Wide-field contact fundus photograph of an infant; camera: Phoenix ICON (100° FOV): 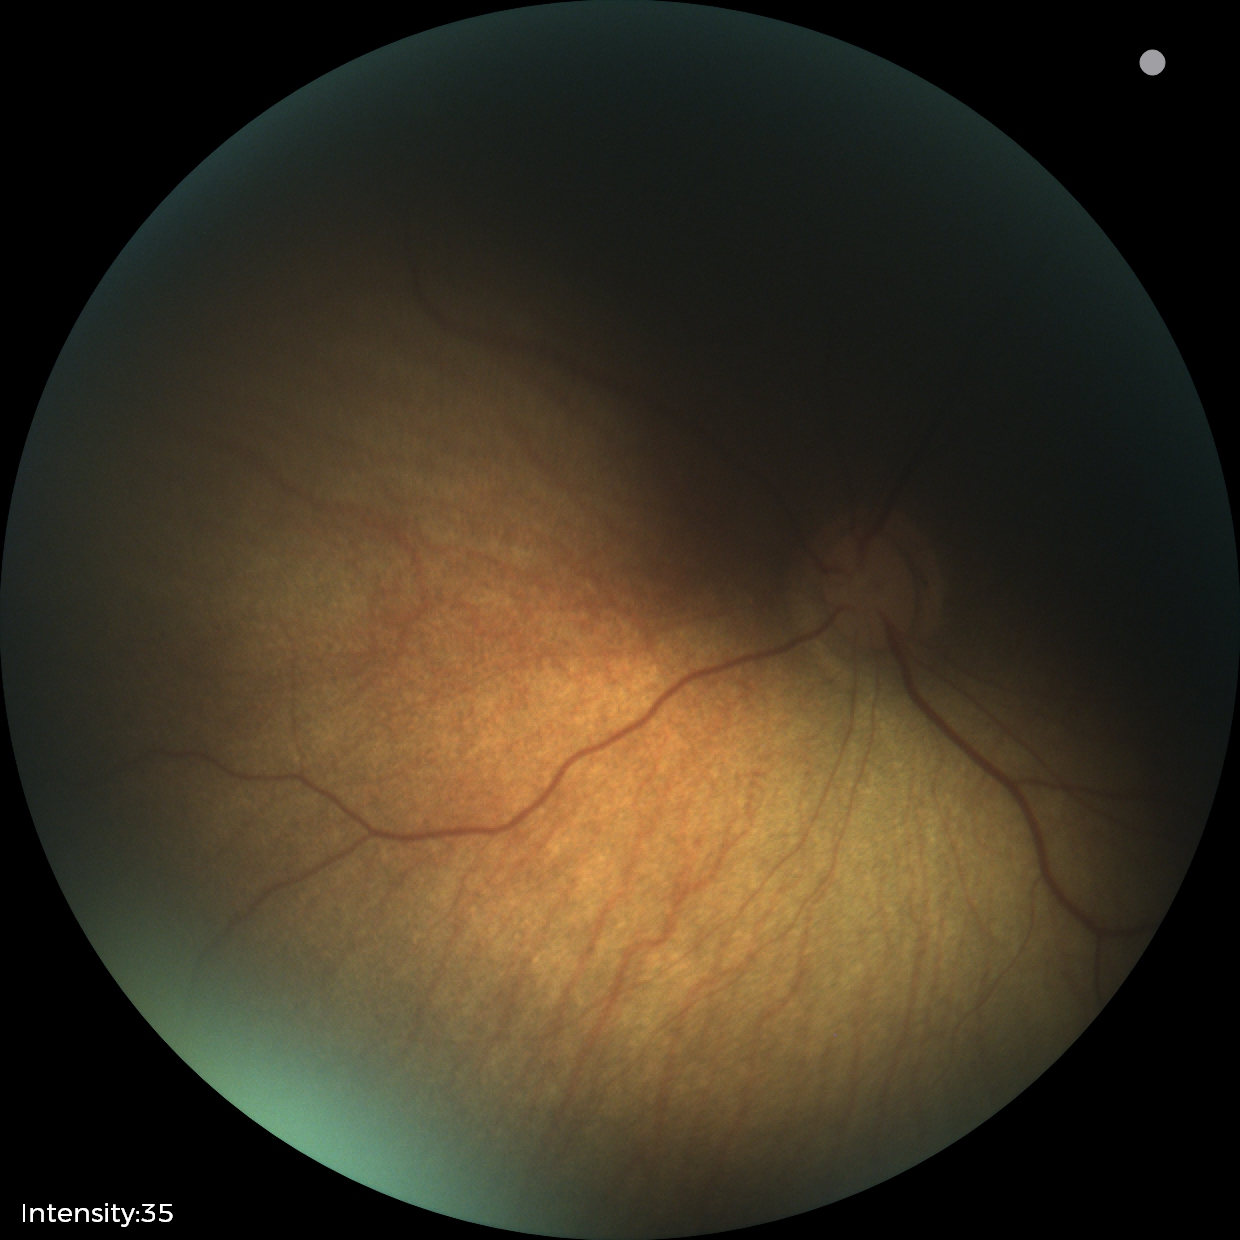 Examination with physiological retinal findings.